CFP — 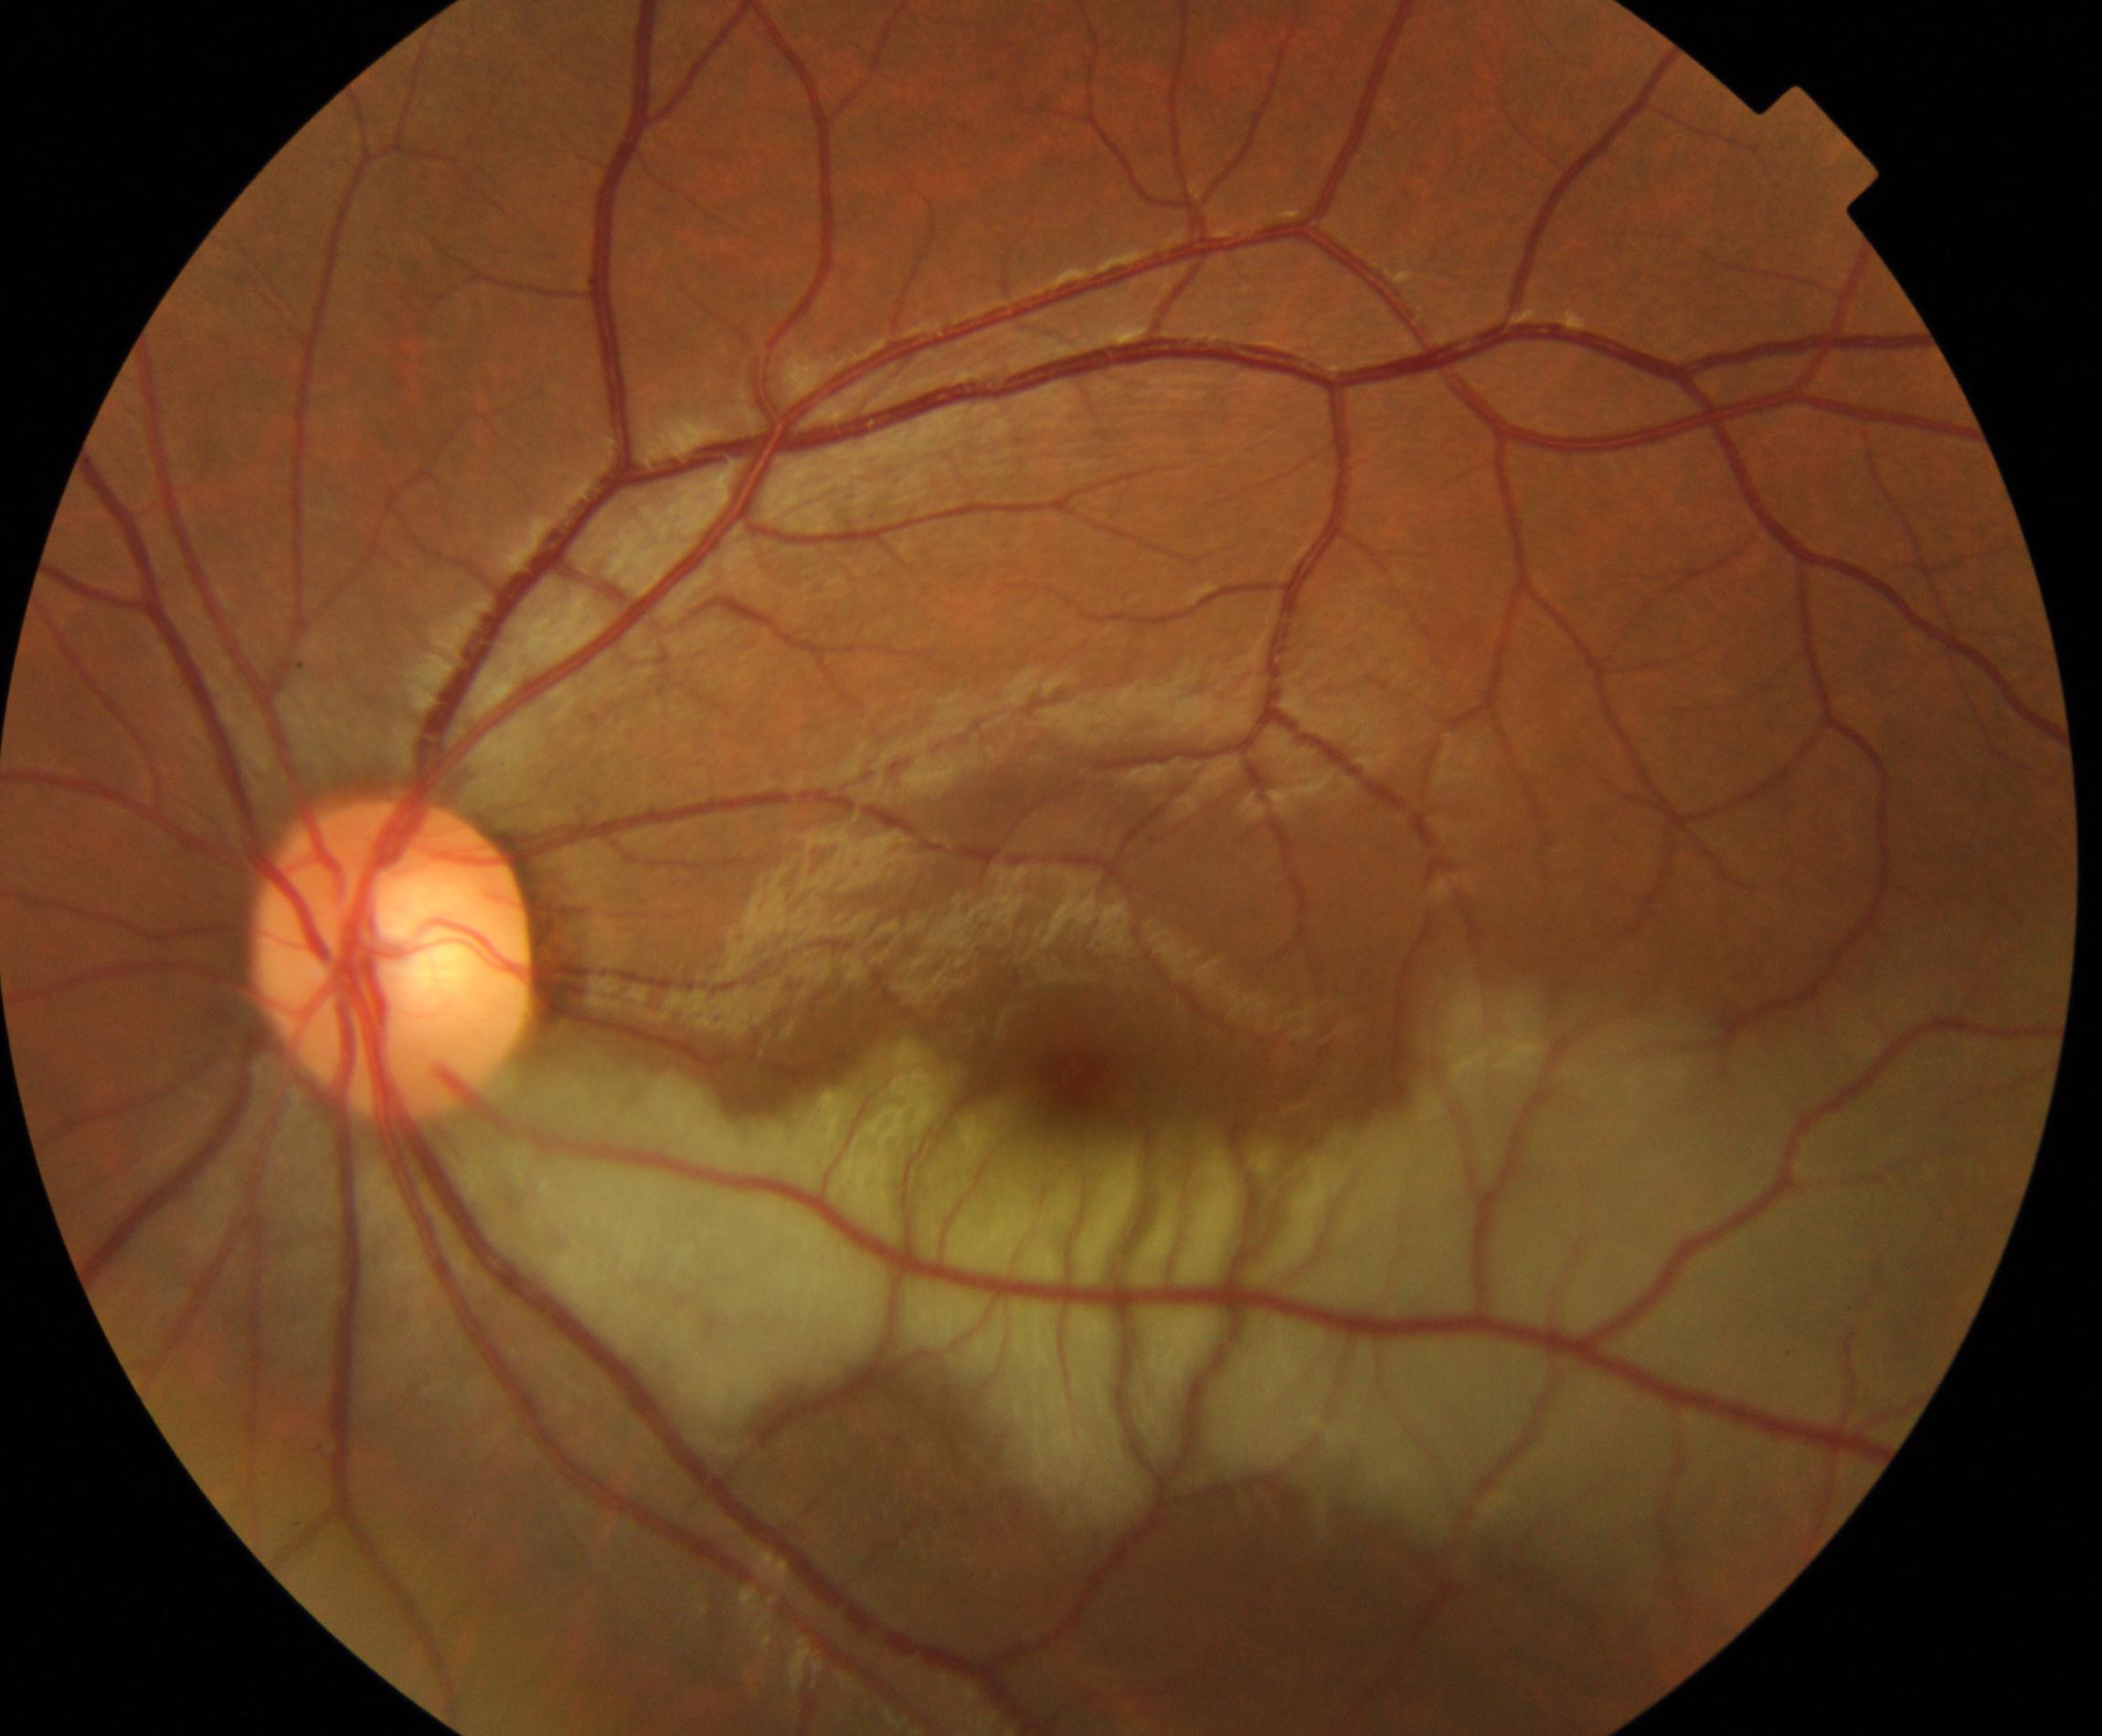
Classification: RAO (retinal artery occlusion). Features include attenuation of arteries and veins with a cherry-red fovea, in contrast to the cloudy white edematous retina affected by the artery occlusion.